Wide-field fundus photograph from neonatal ROP screening; acquired on the Clarity RetCam 3; 640 x 480 pixels:
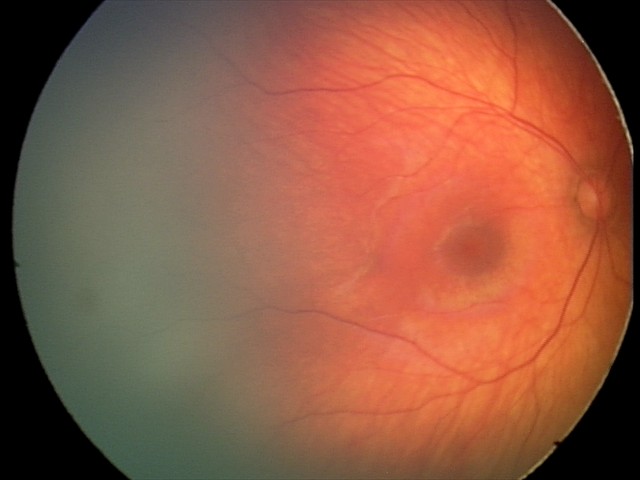

Q: What is the diagnosis from this examination?
A: retinal hemorrhages